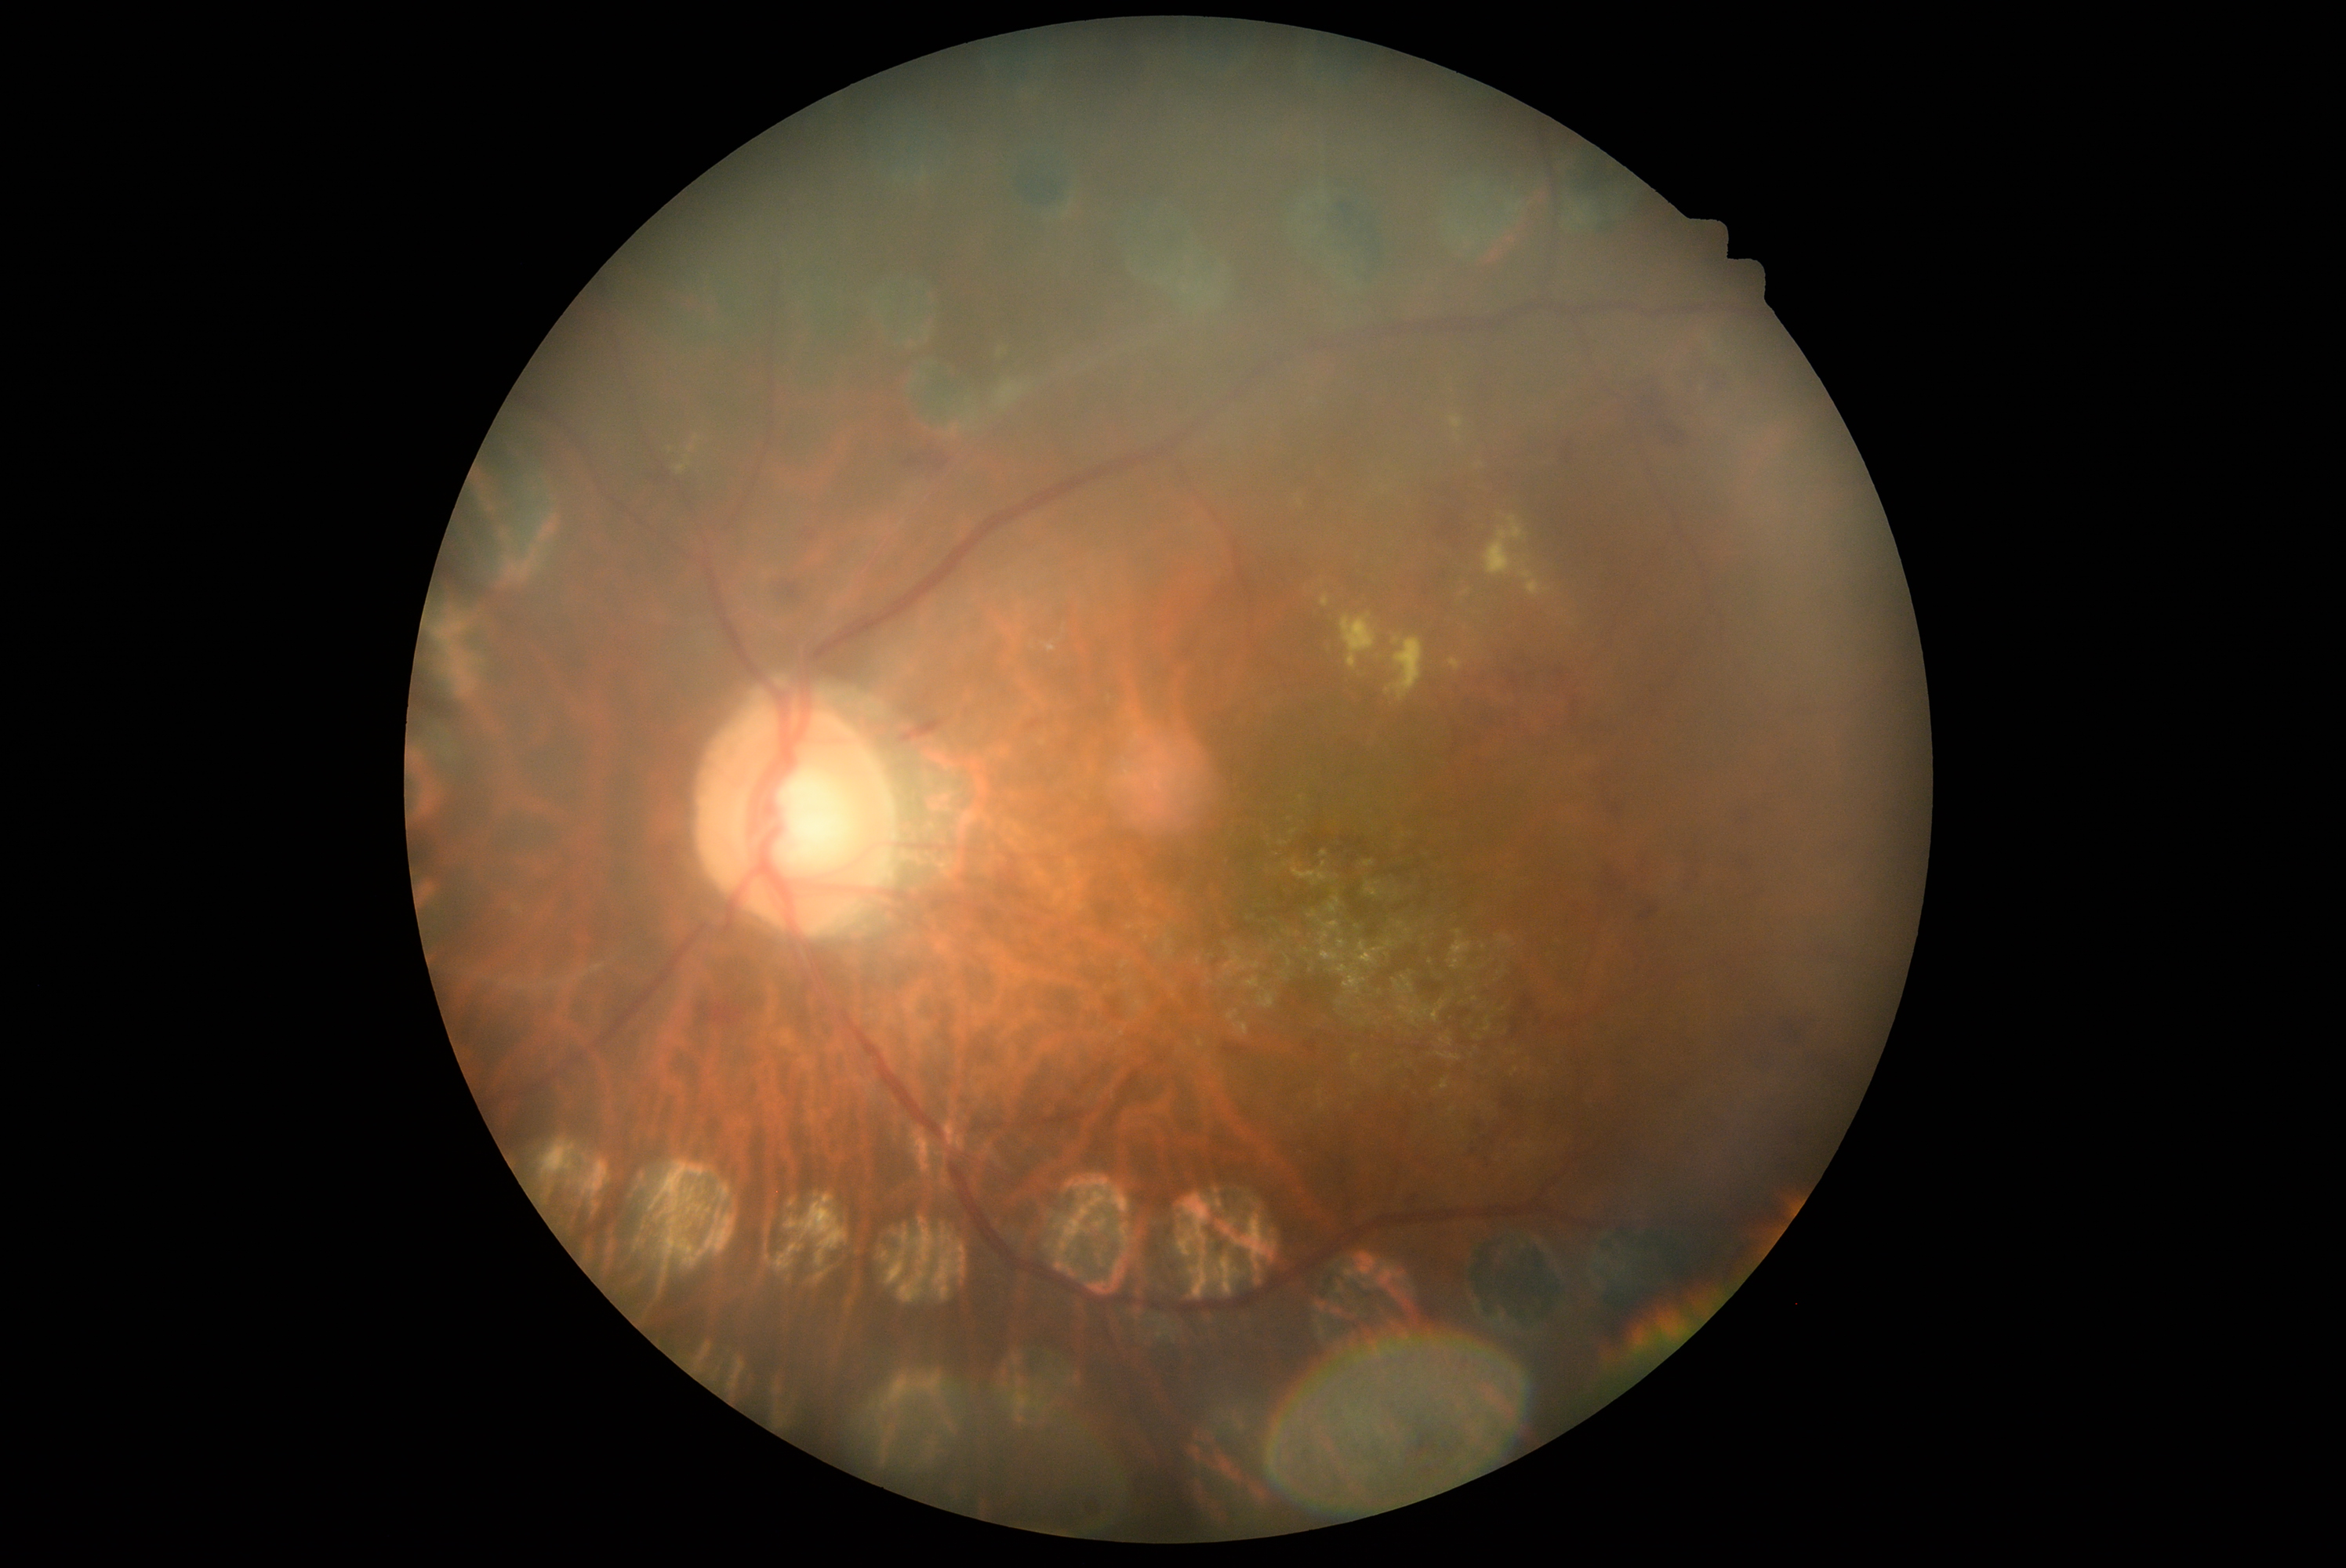

The retinopathy is classified as non-proliferative diabetic retinopathy.
DR severity is 2/4.